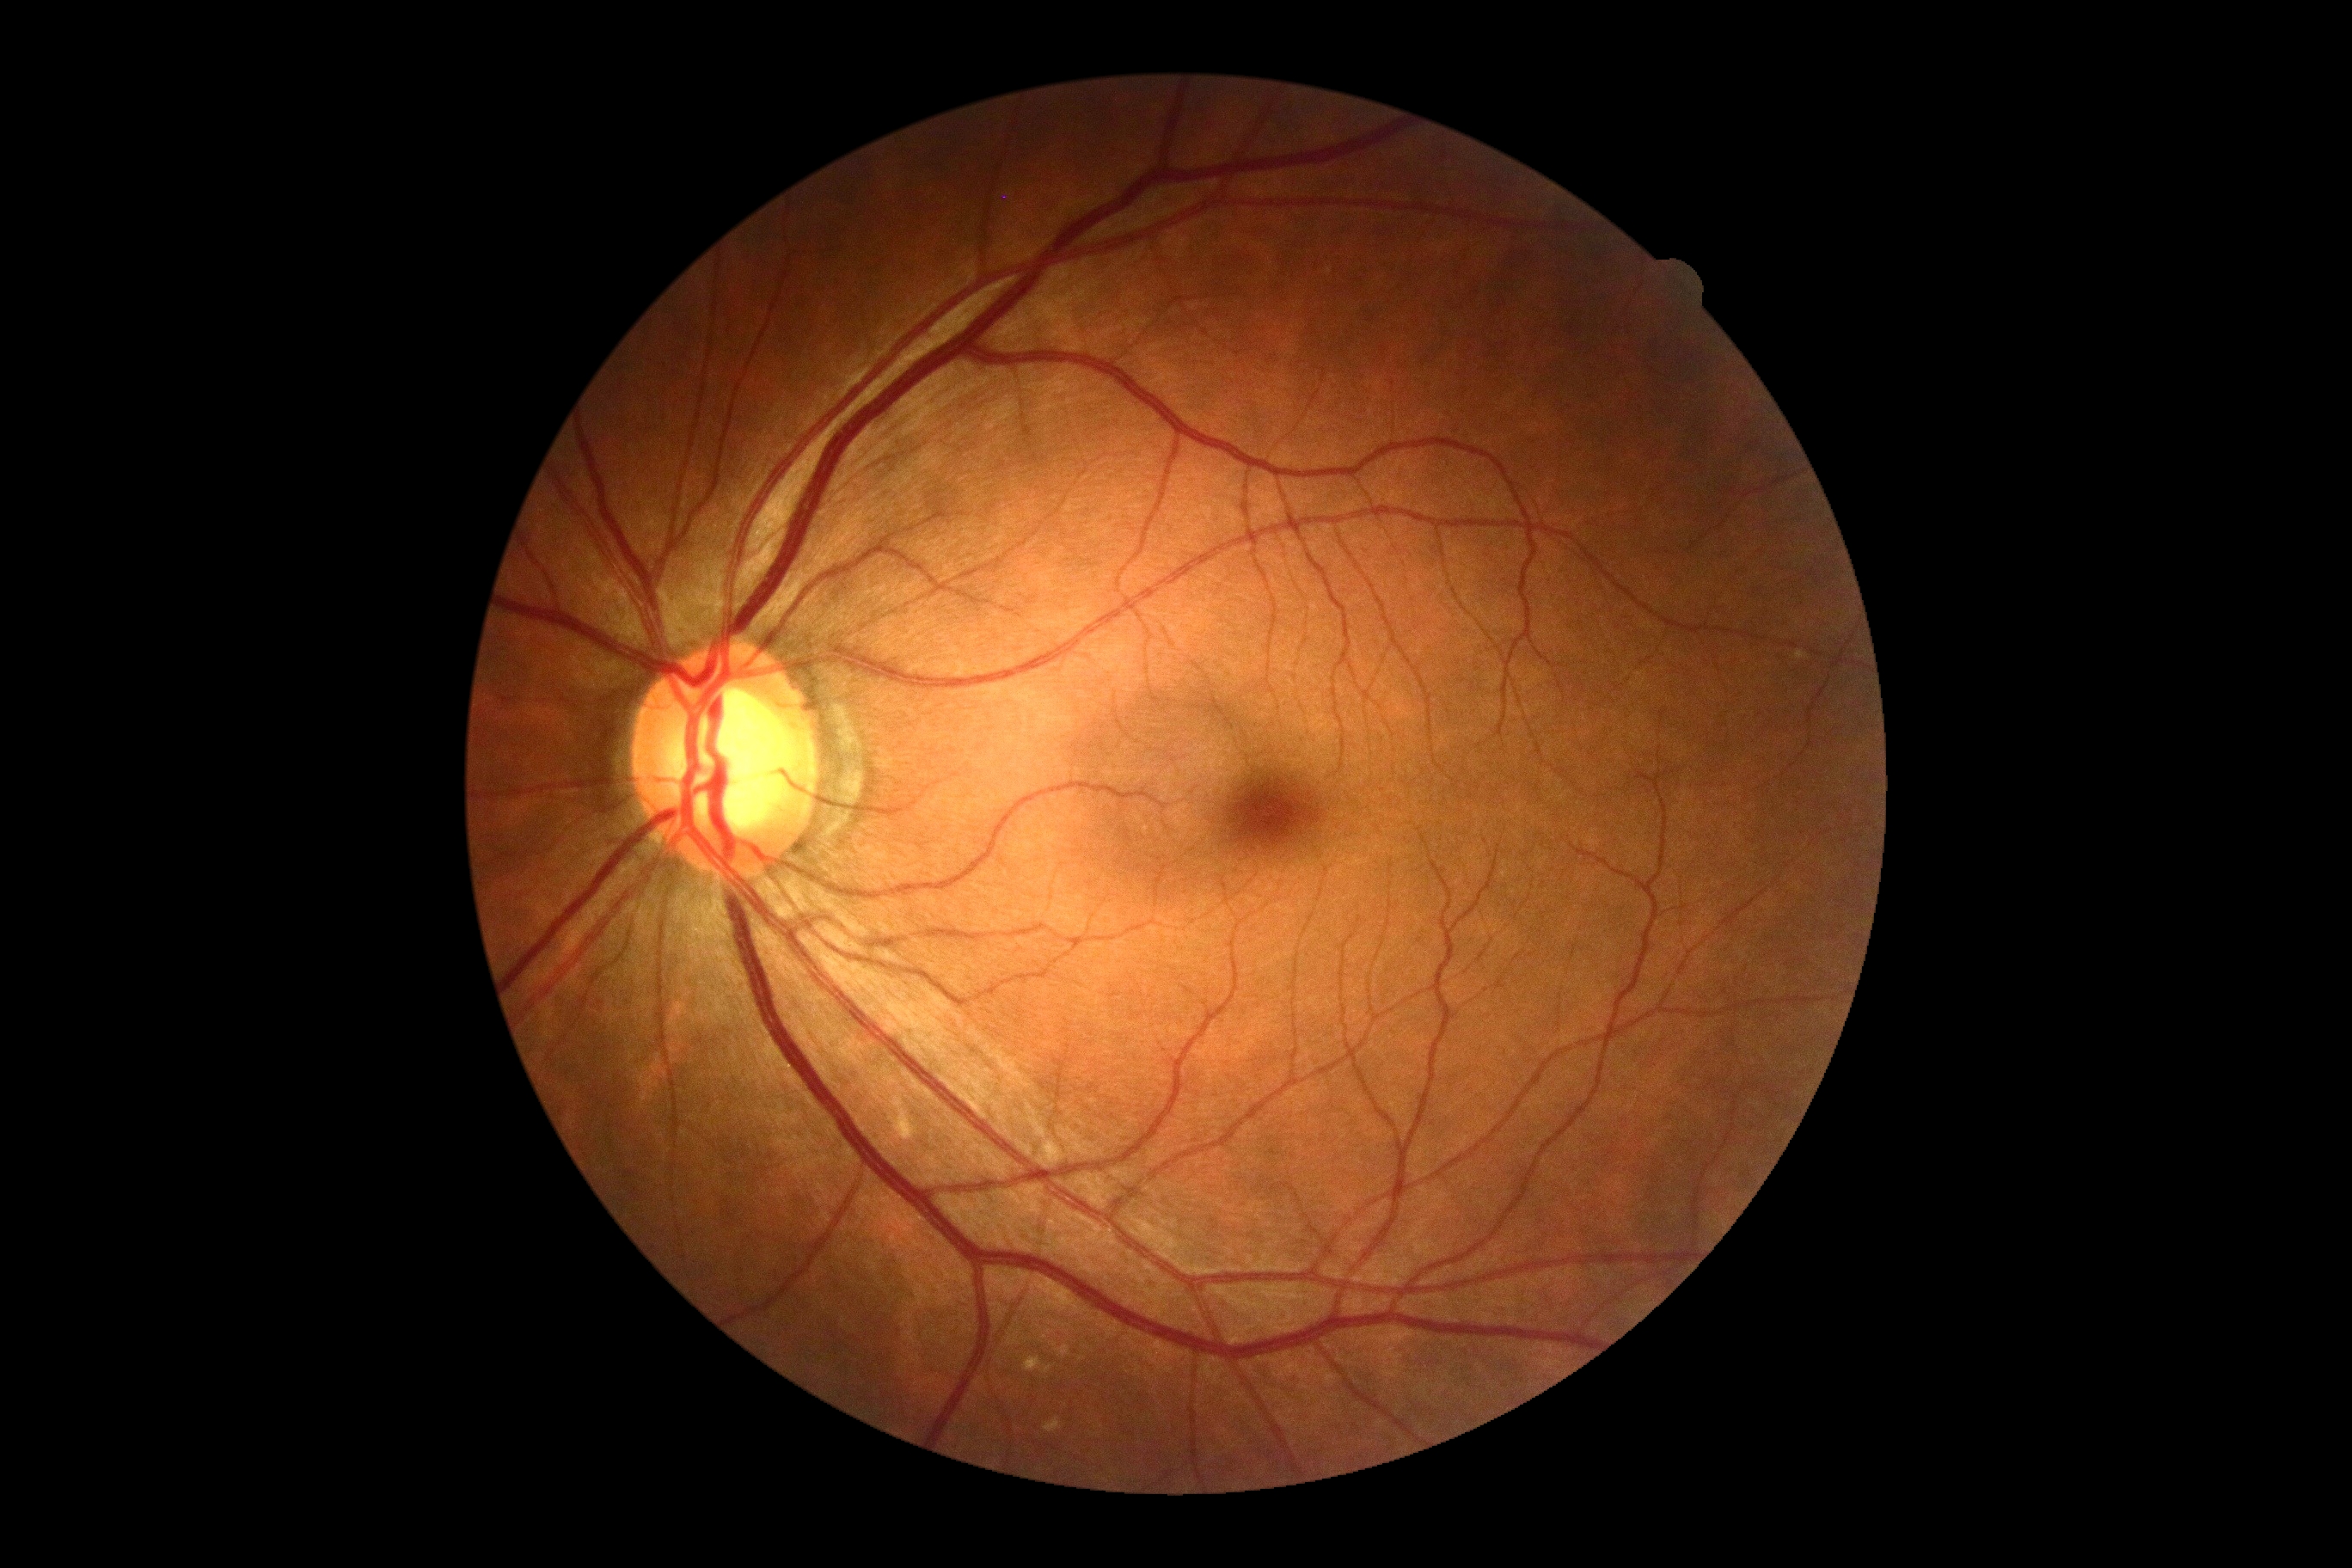
Diabetic retinopathy grade: no apparent retinopathy (0). No signs of diabetic retinopathy.